Infant wide-field fundus photograph · 640x480px · 130° field of view (Clarity RetCam 3).
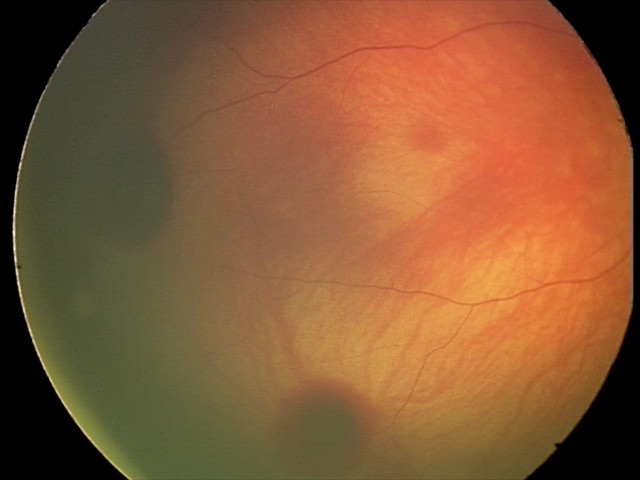 Screening examination consistent with retinal hemorrhages.